848x848px:
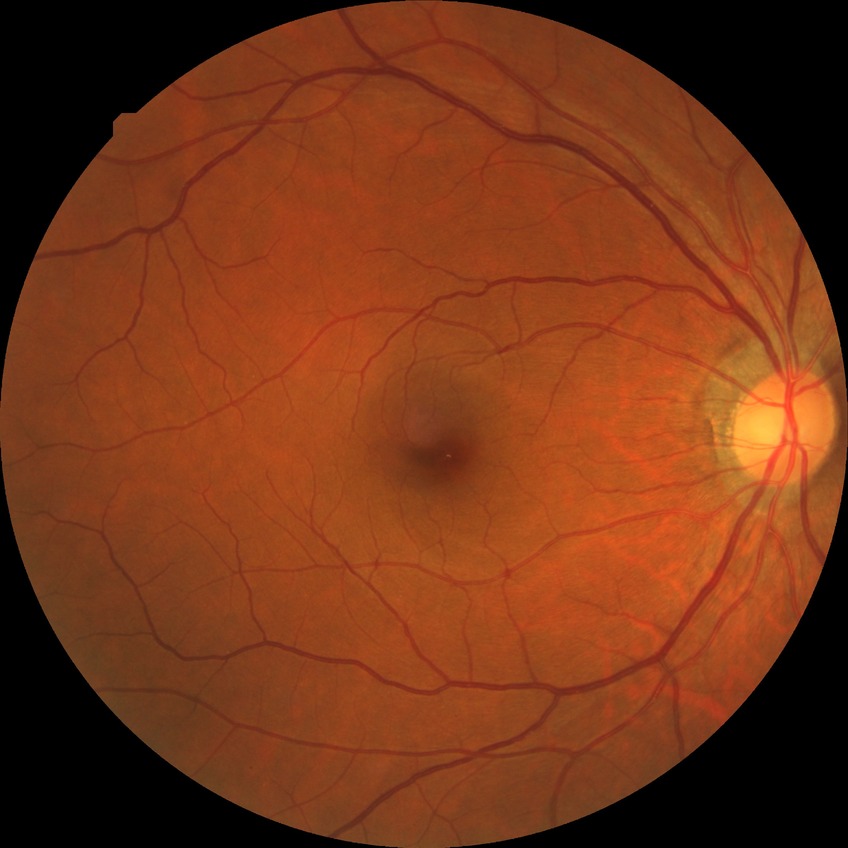
DR impression: no signs of DR; Davis stage: NDR.